Wide-field contact fundus photograph of an infant; camera: Natus RetCam Envision (130° FOV): 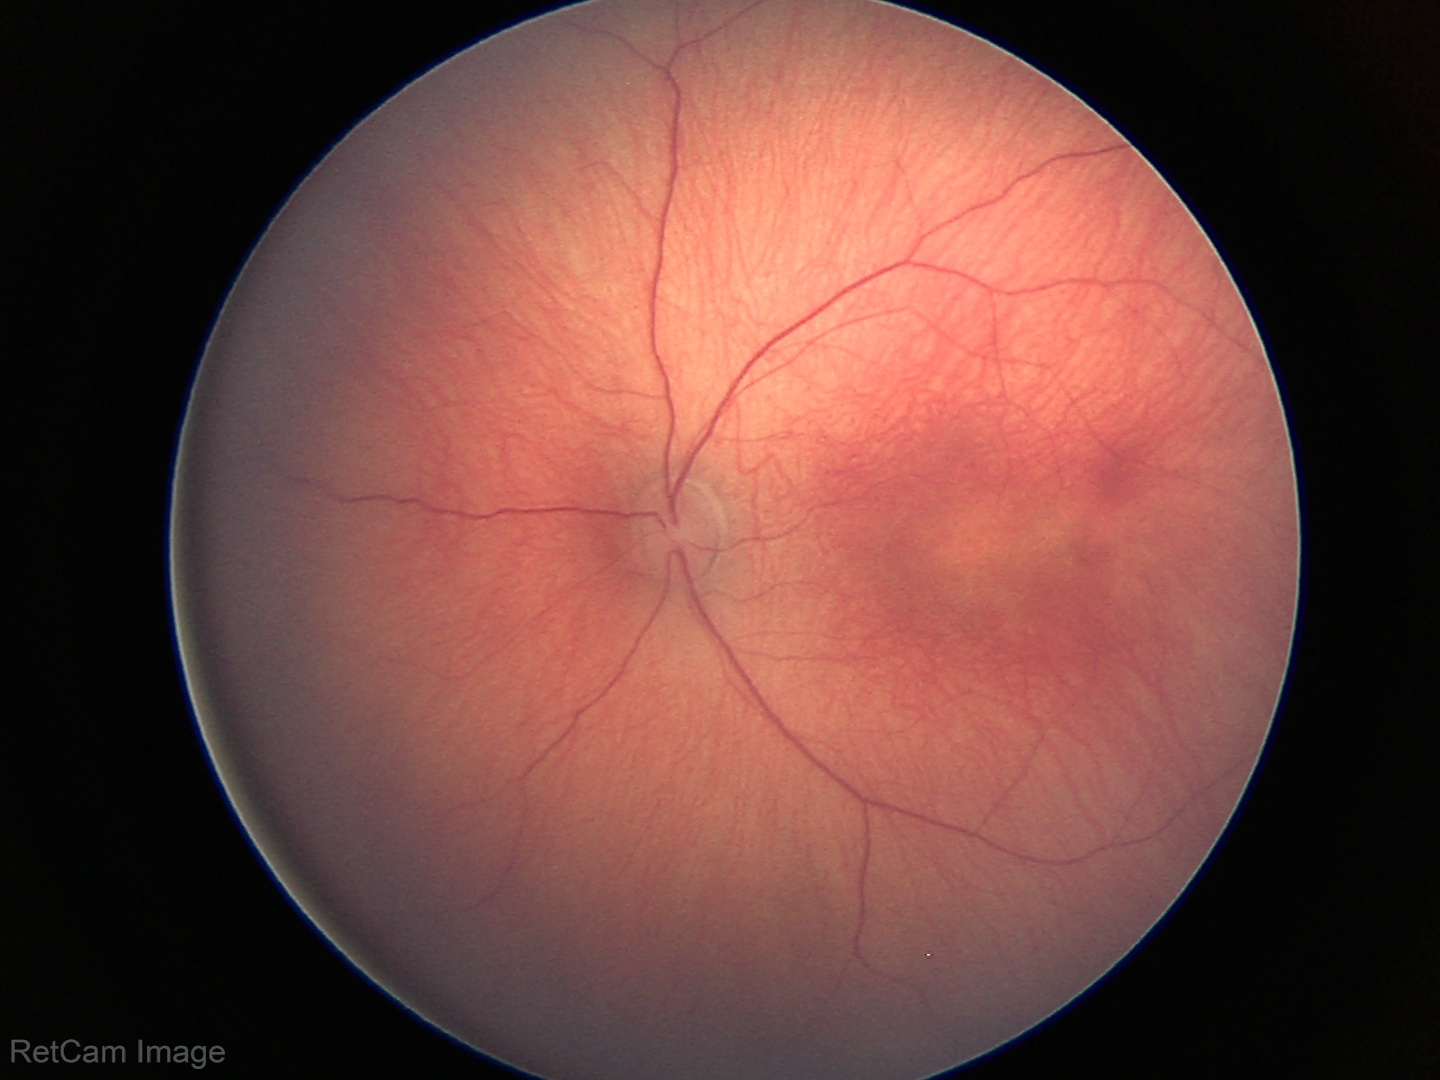
No plus disease.
From an examination with diagnosis of status post retinopathy of prematurity (ROP).